200-degree field of view, ultra-widefield fundus photograph, 1924 x 1556 pixels: 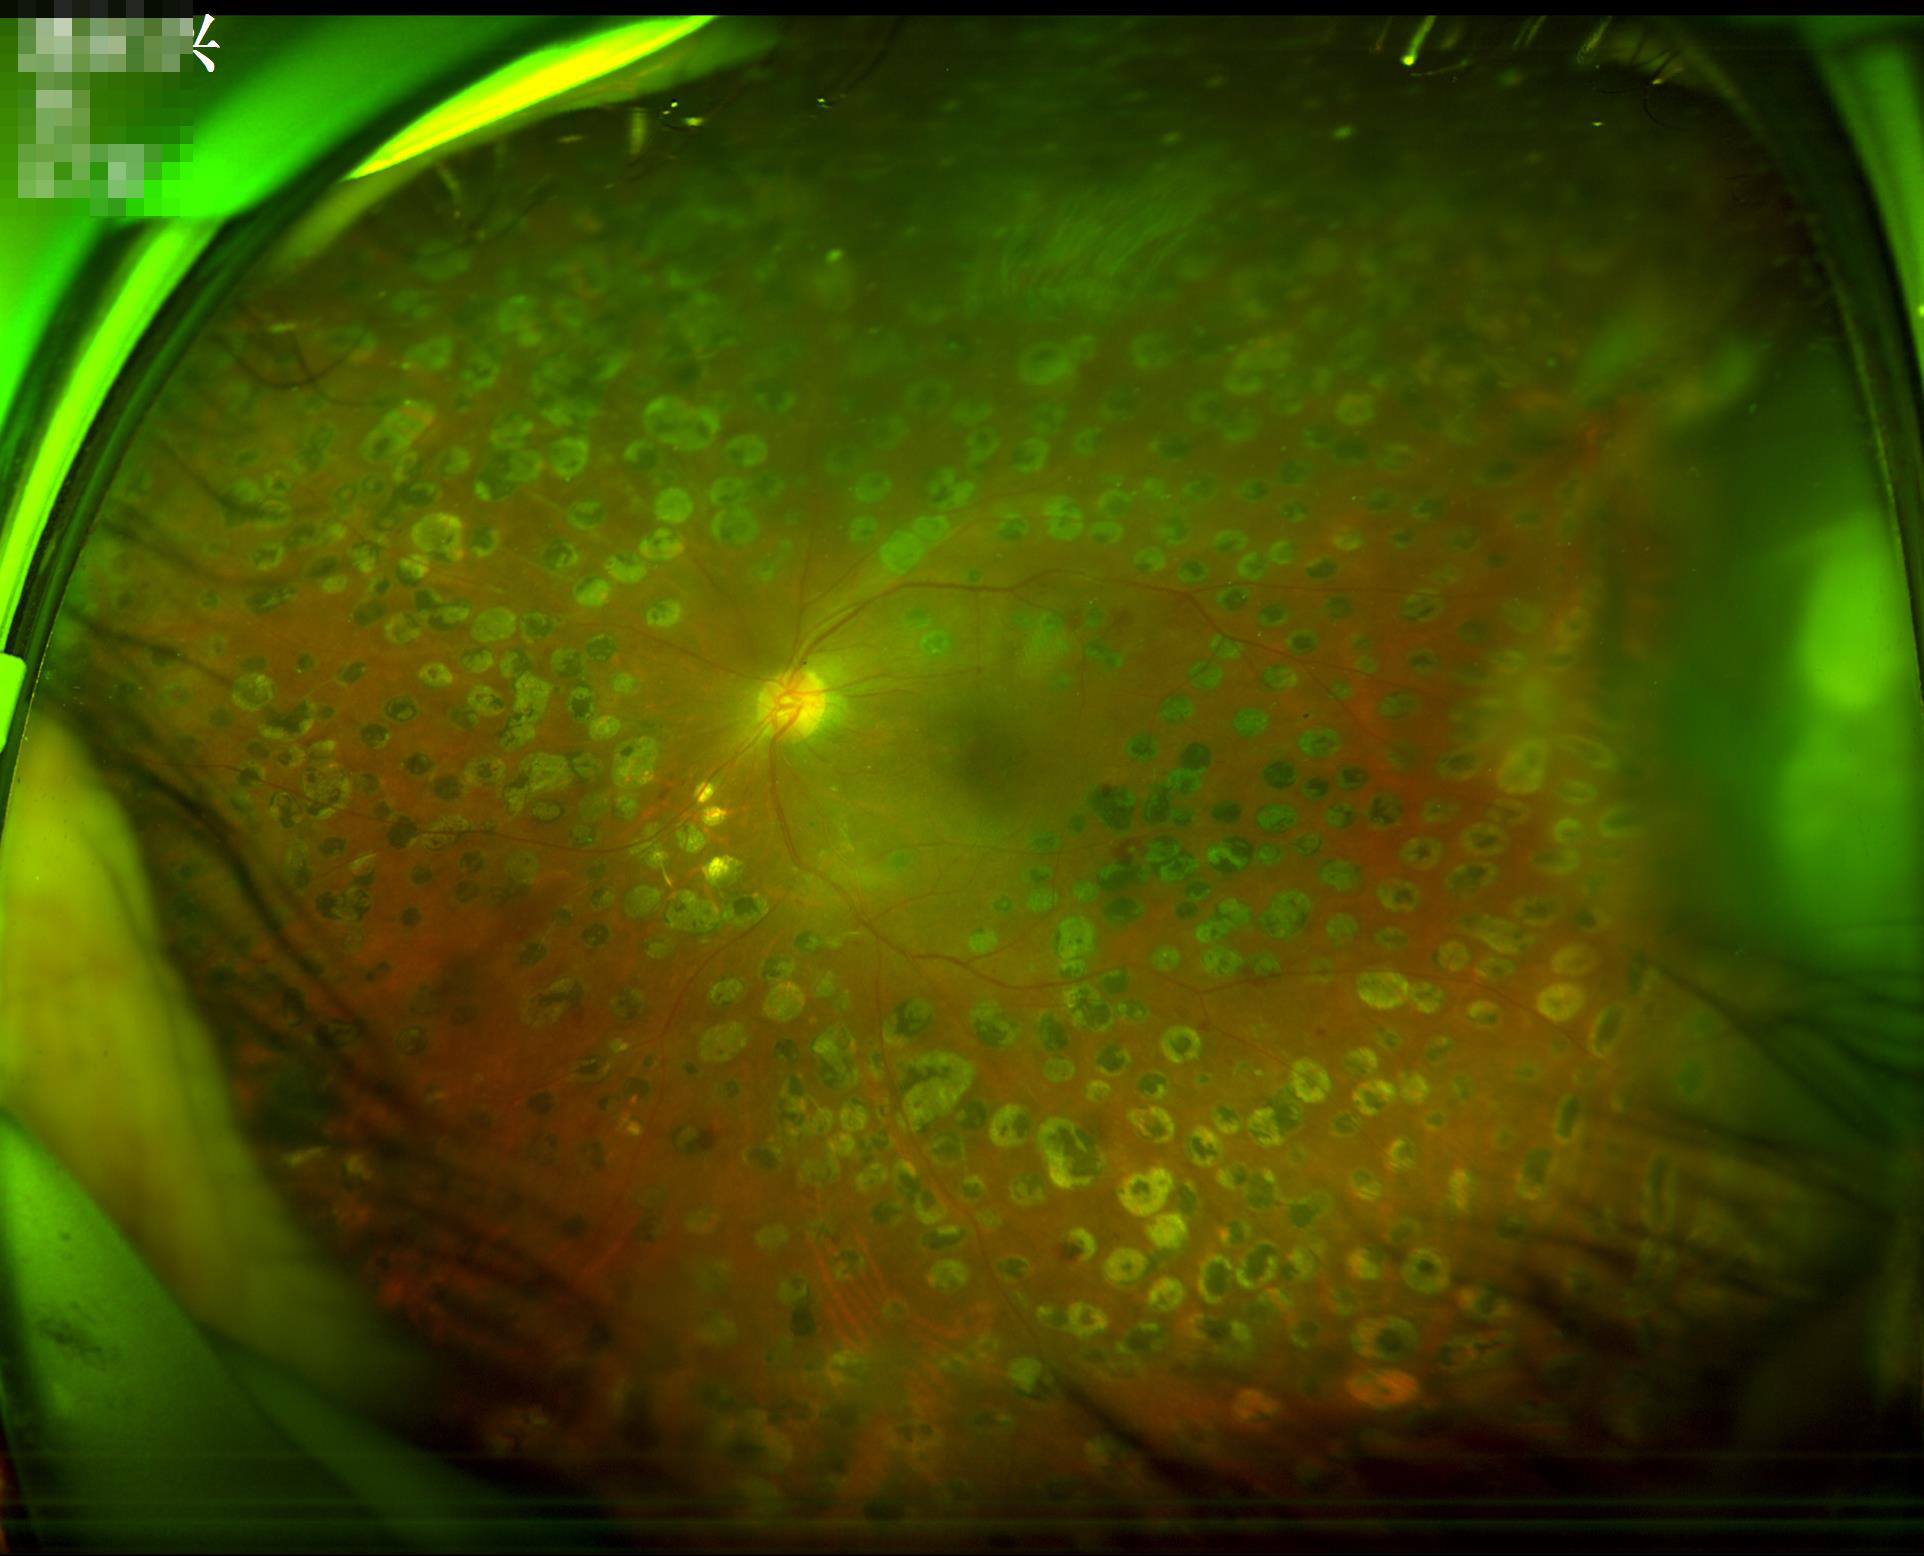
{
  "illumination": "satisfactory",
  "overall_quality": "good",
  "clarity": "blurry",
  "contrast": "good"
}